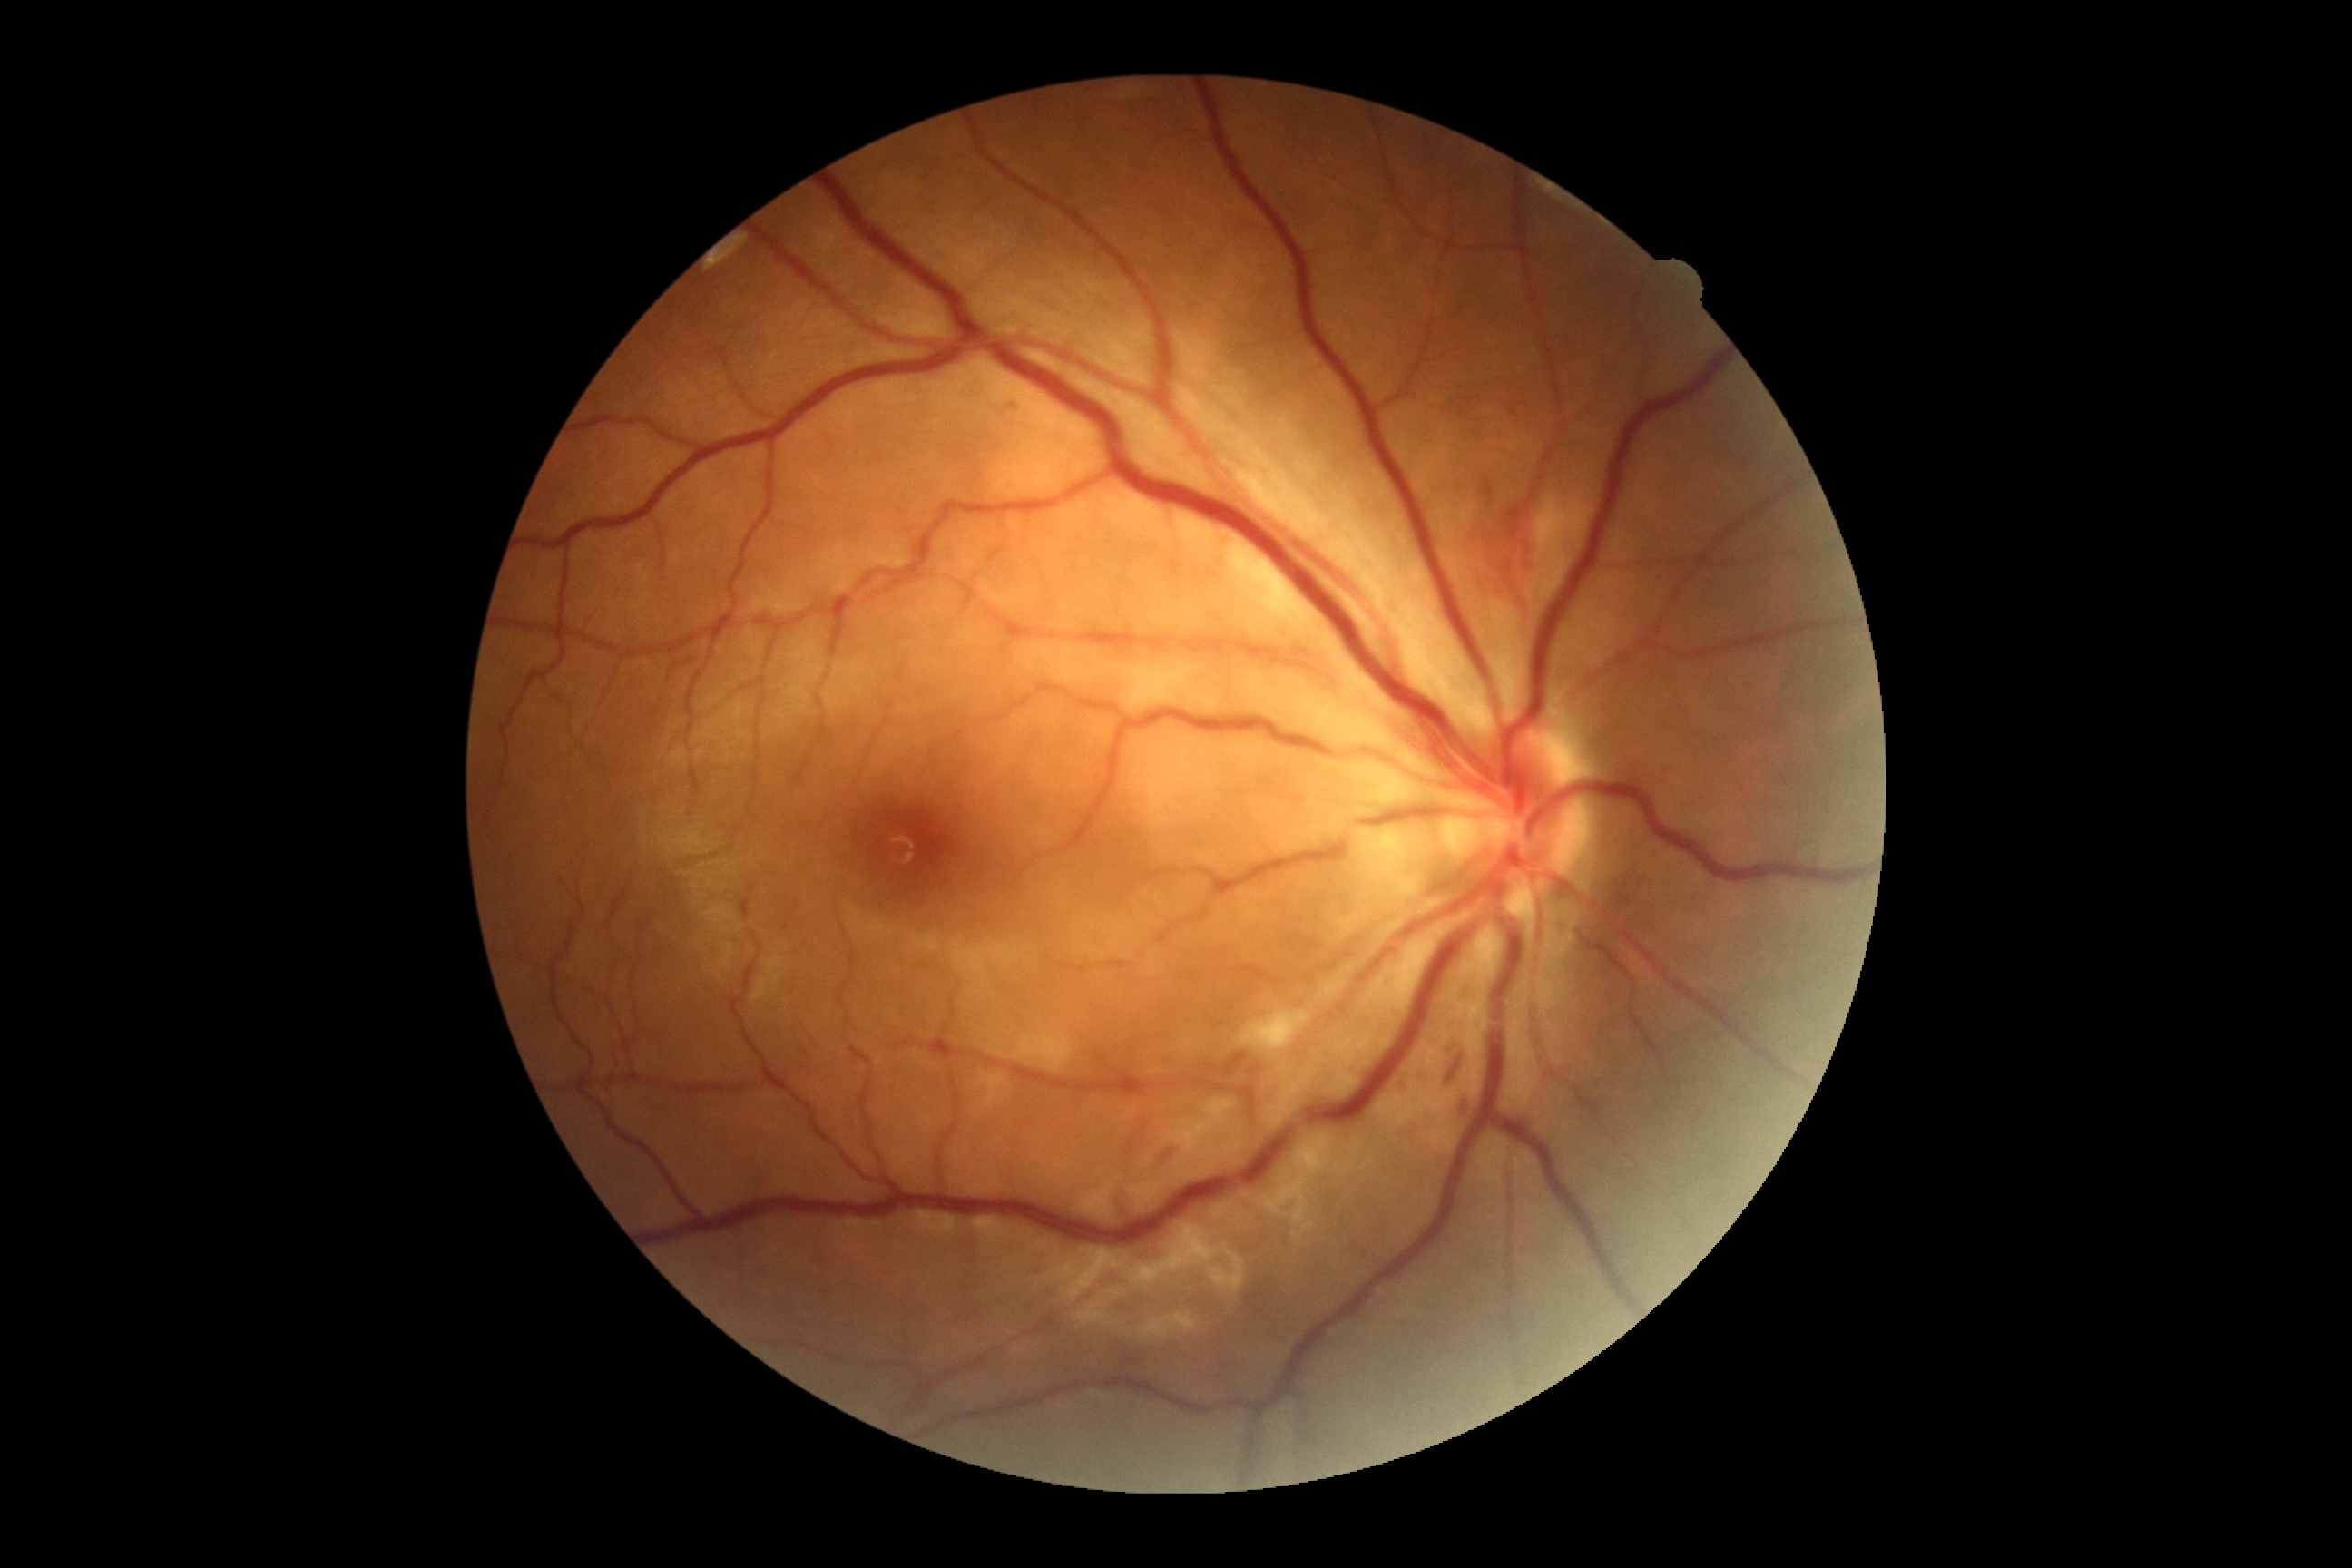
retinopathy: 2